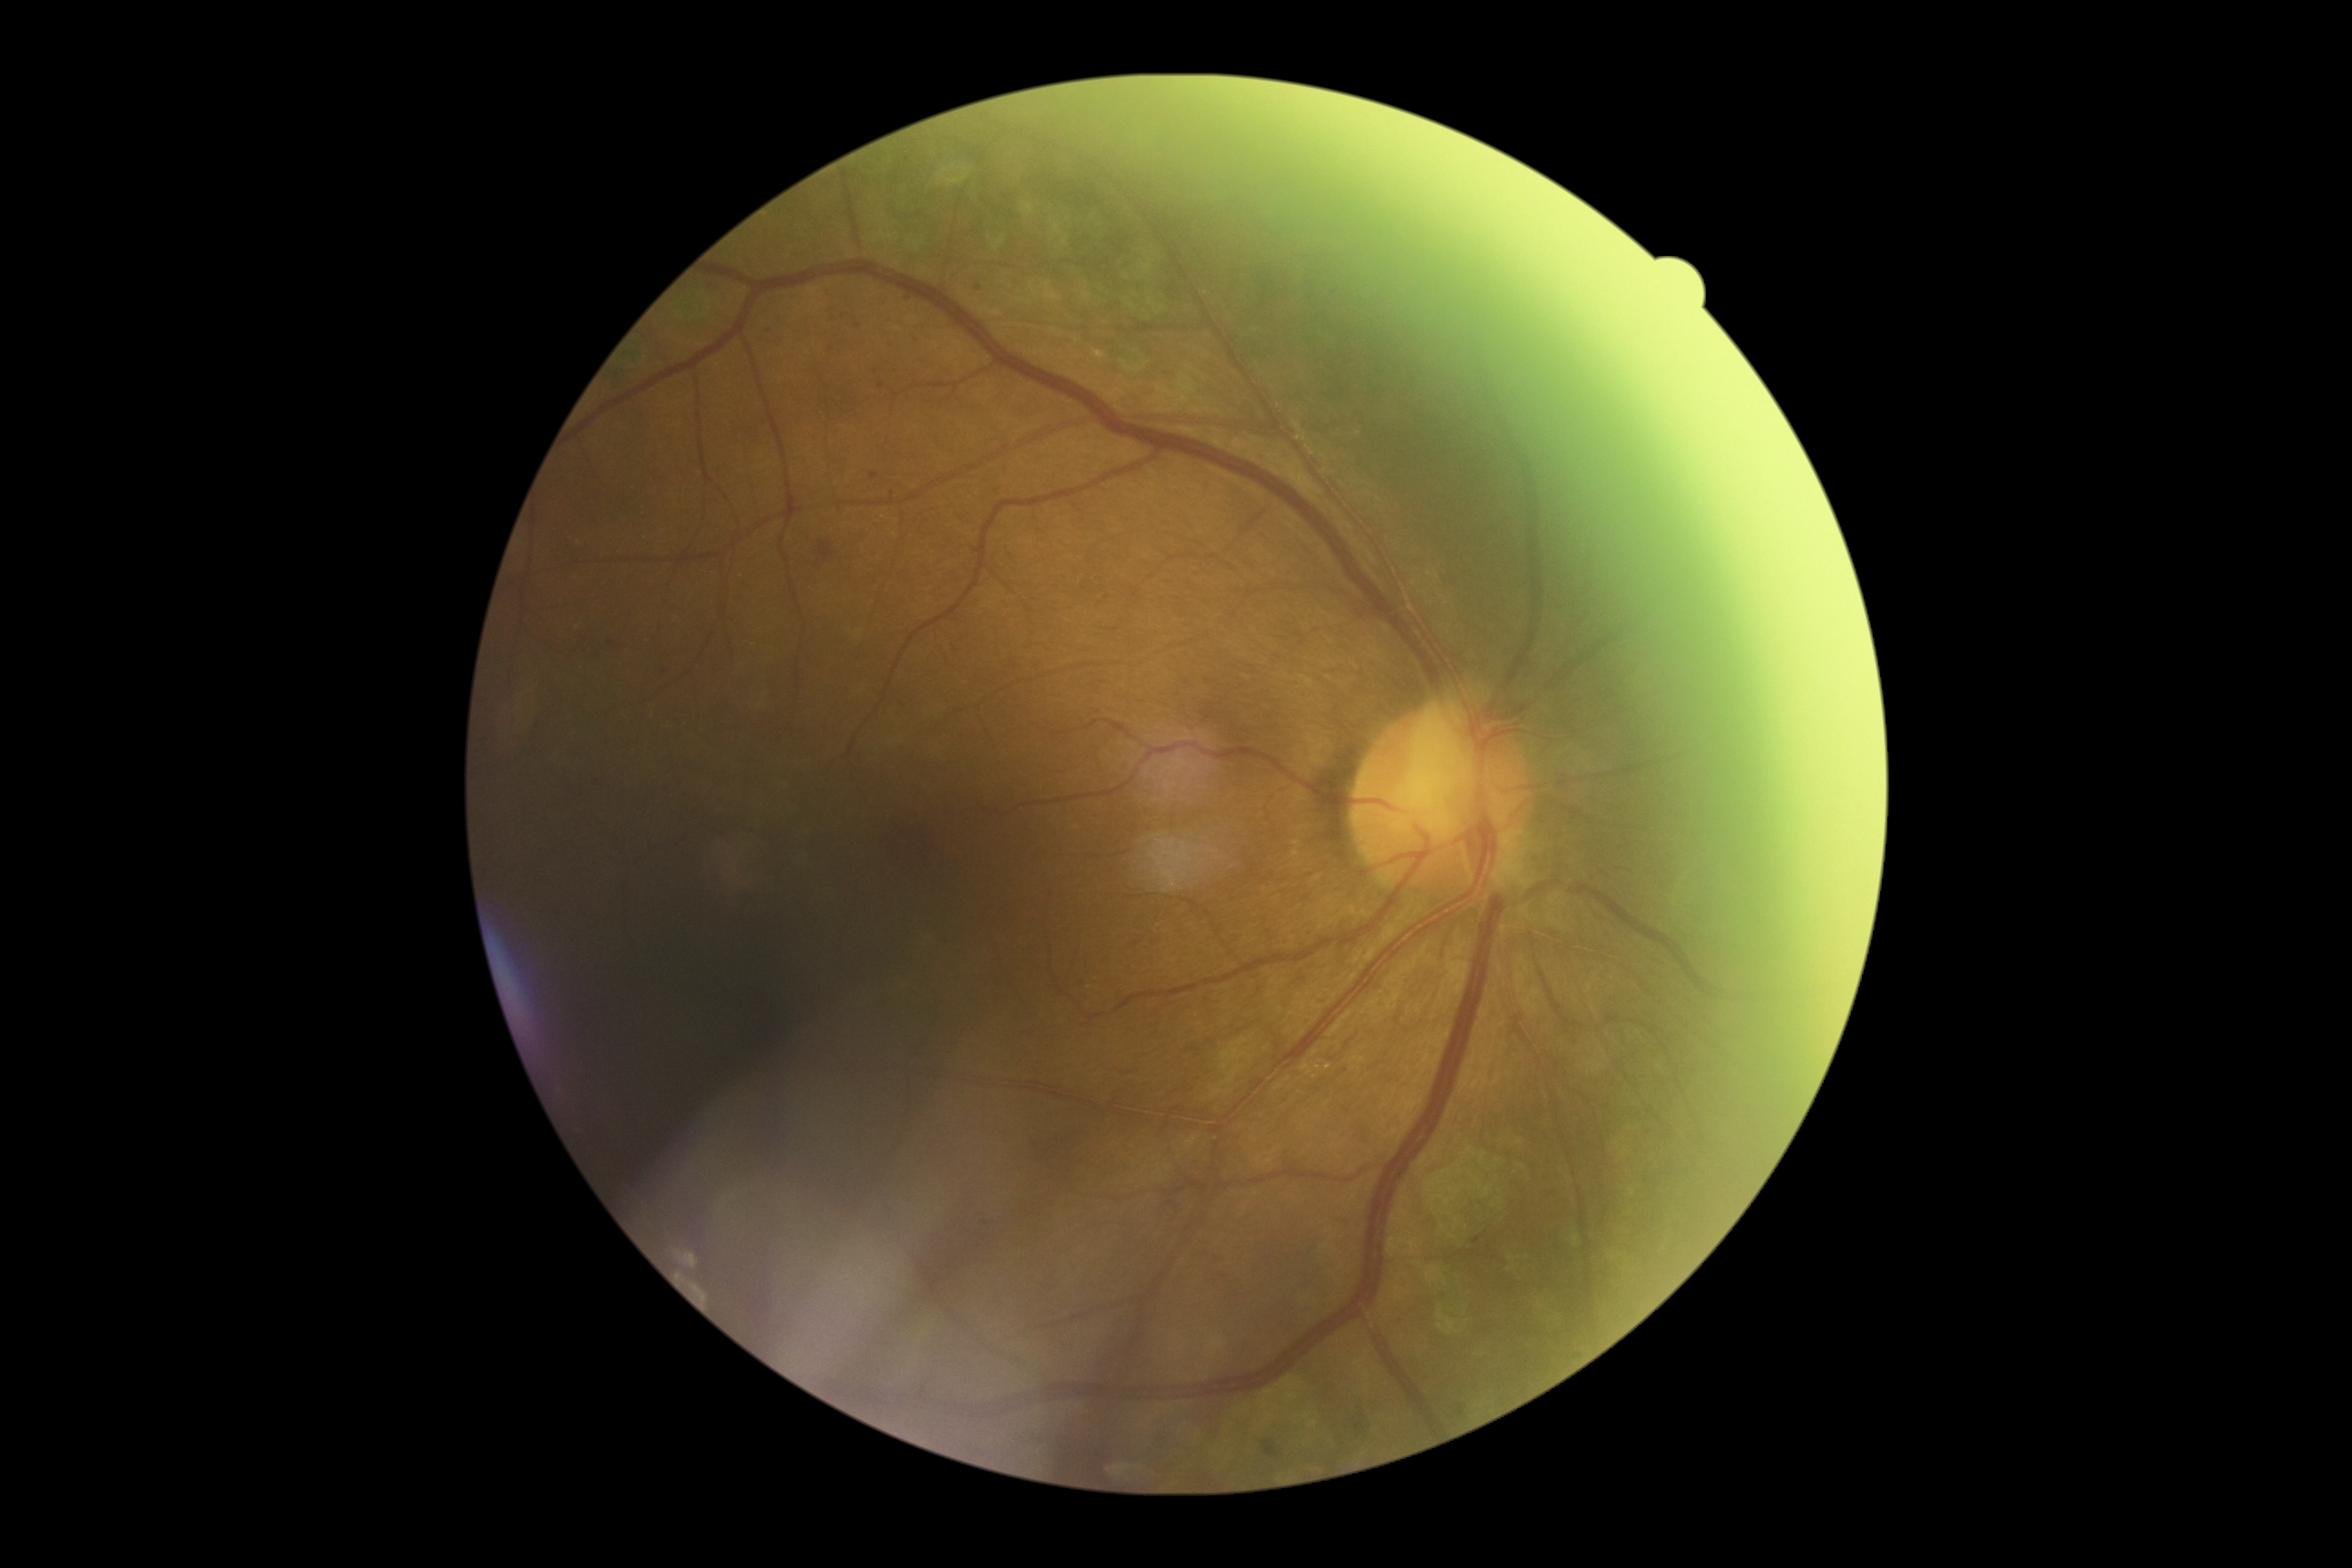 Diabetic retinopathy (DR): grade 2 (moderate NPDR).